CFP
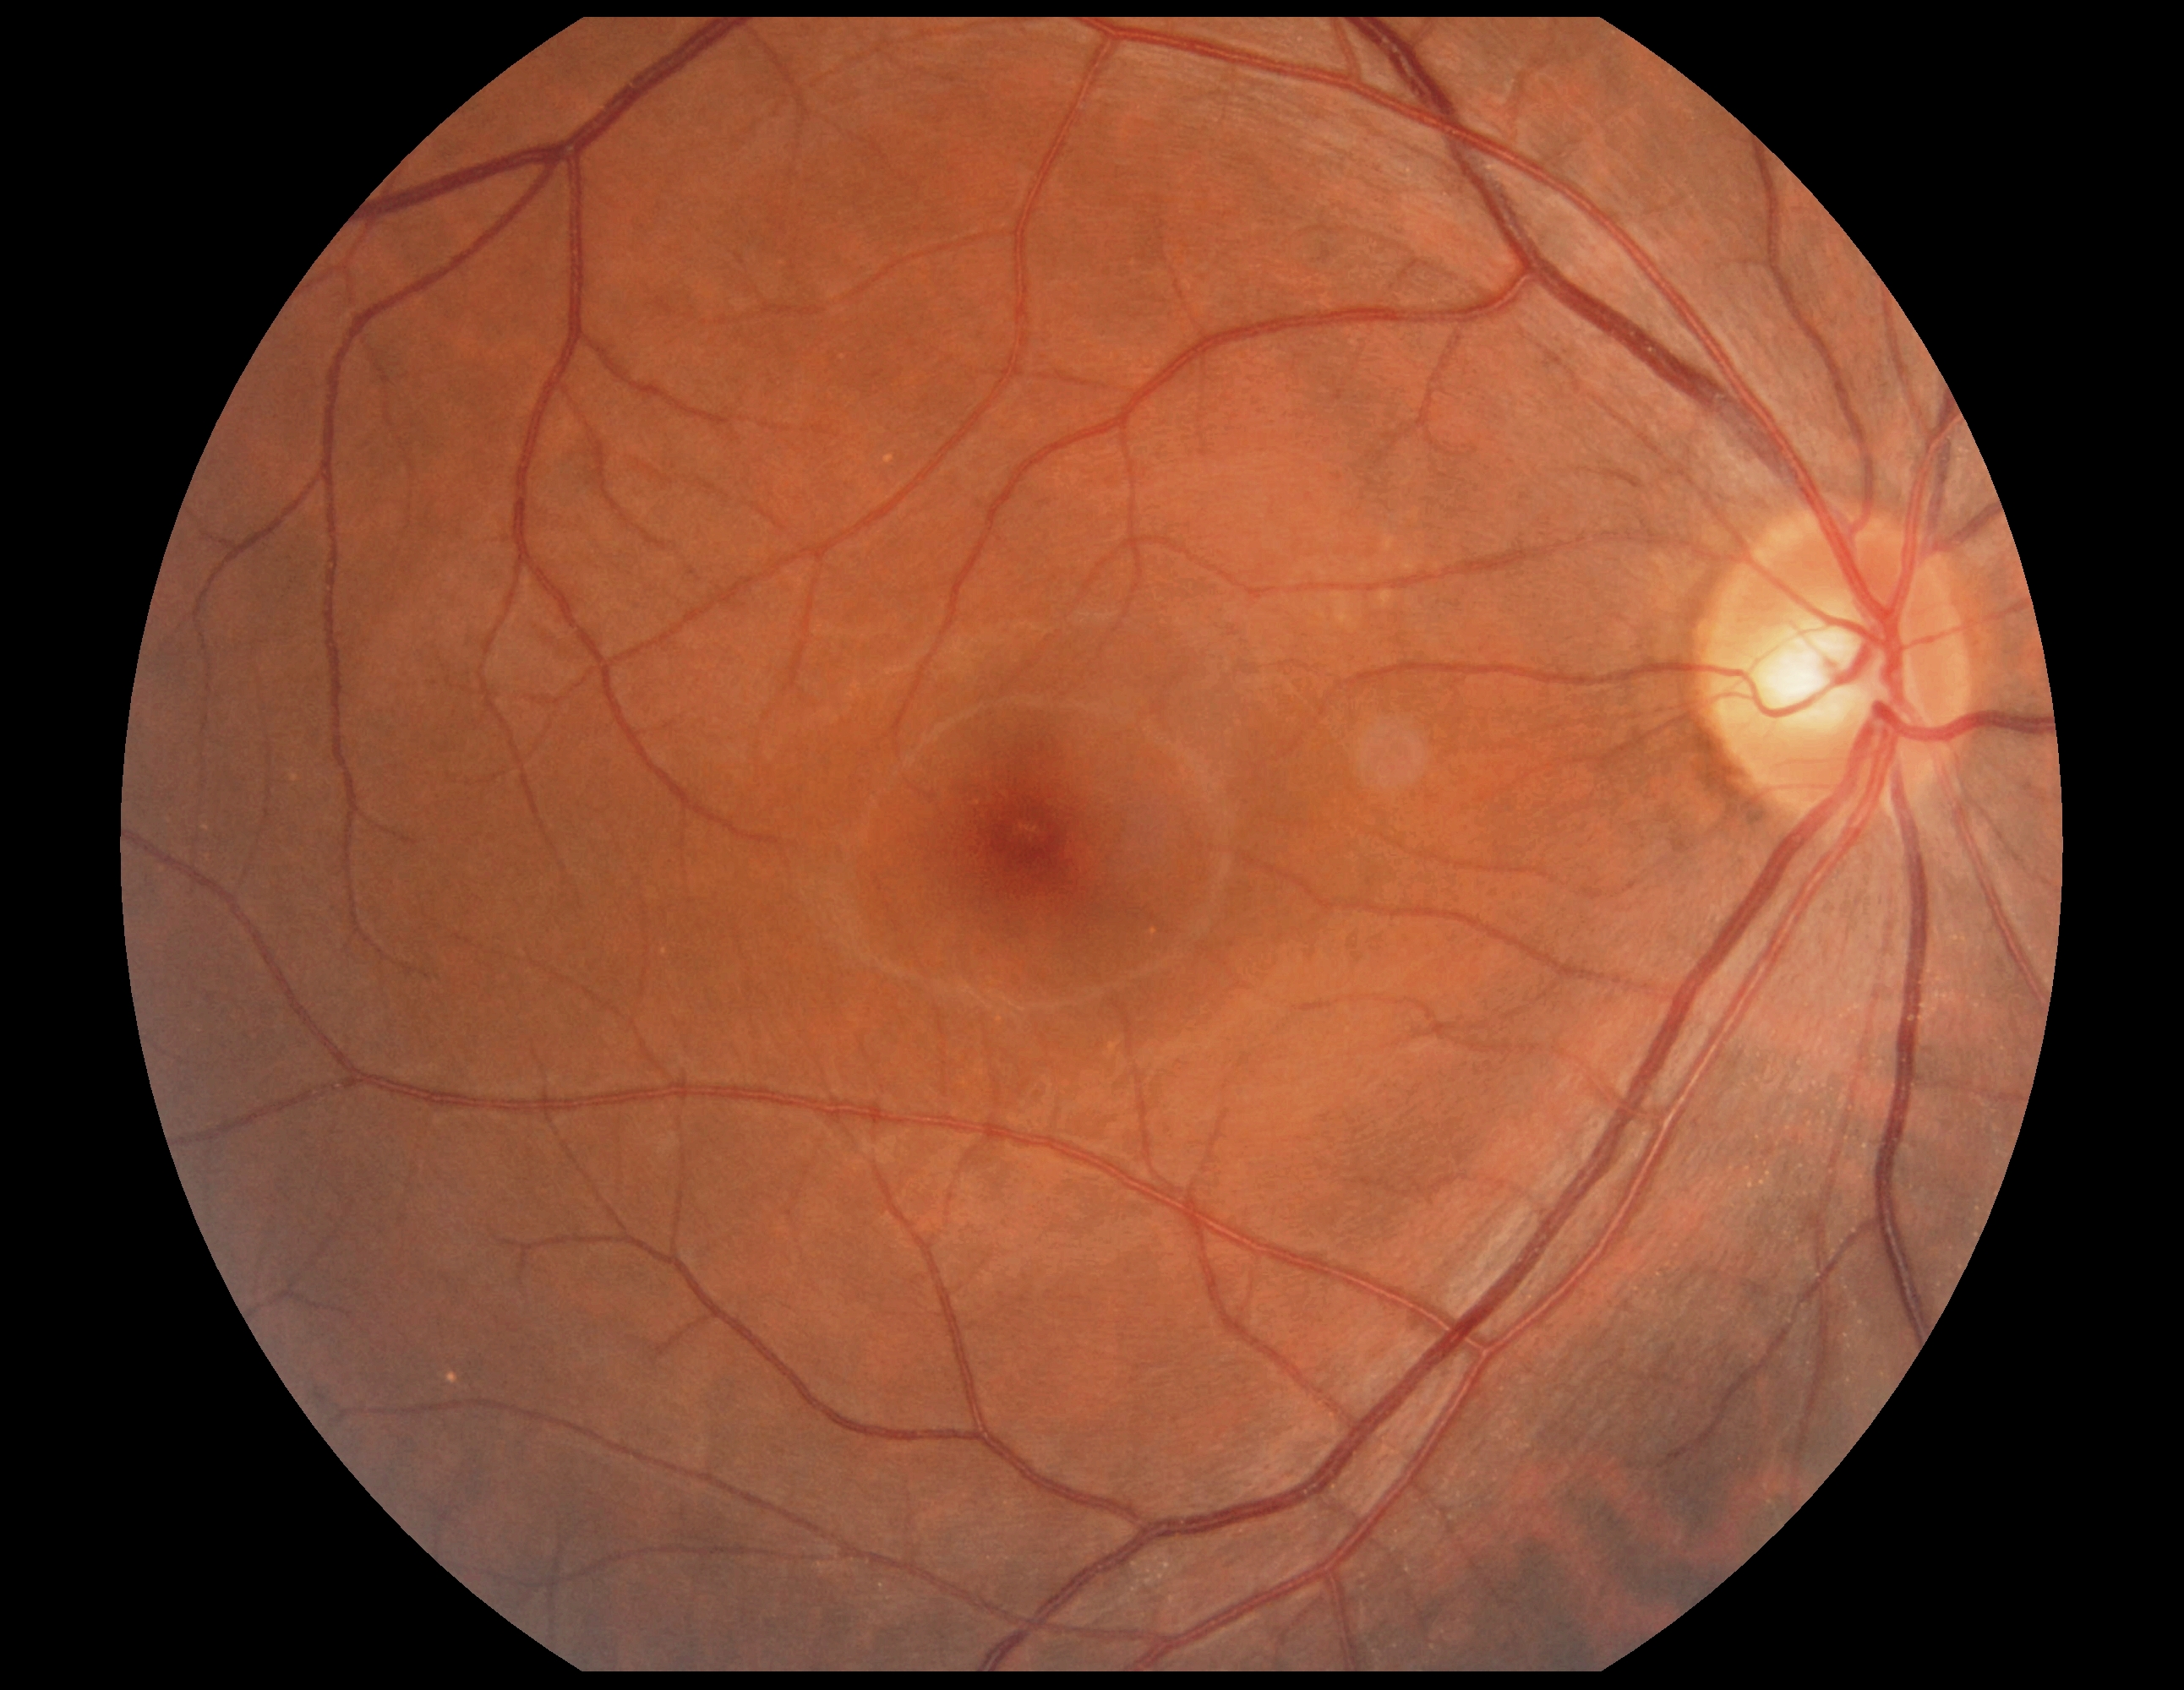 No signs of diabetic retinopathy. DR grade: 0 (no apparent retinopathy).